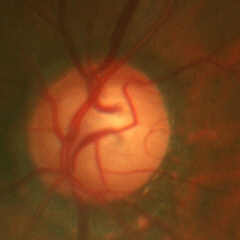
This fundus photograph shows advanced glaucoma.